45° FOV · image size 2352x1568 · CFP
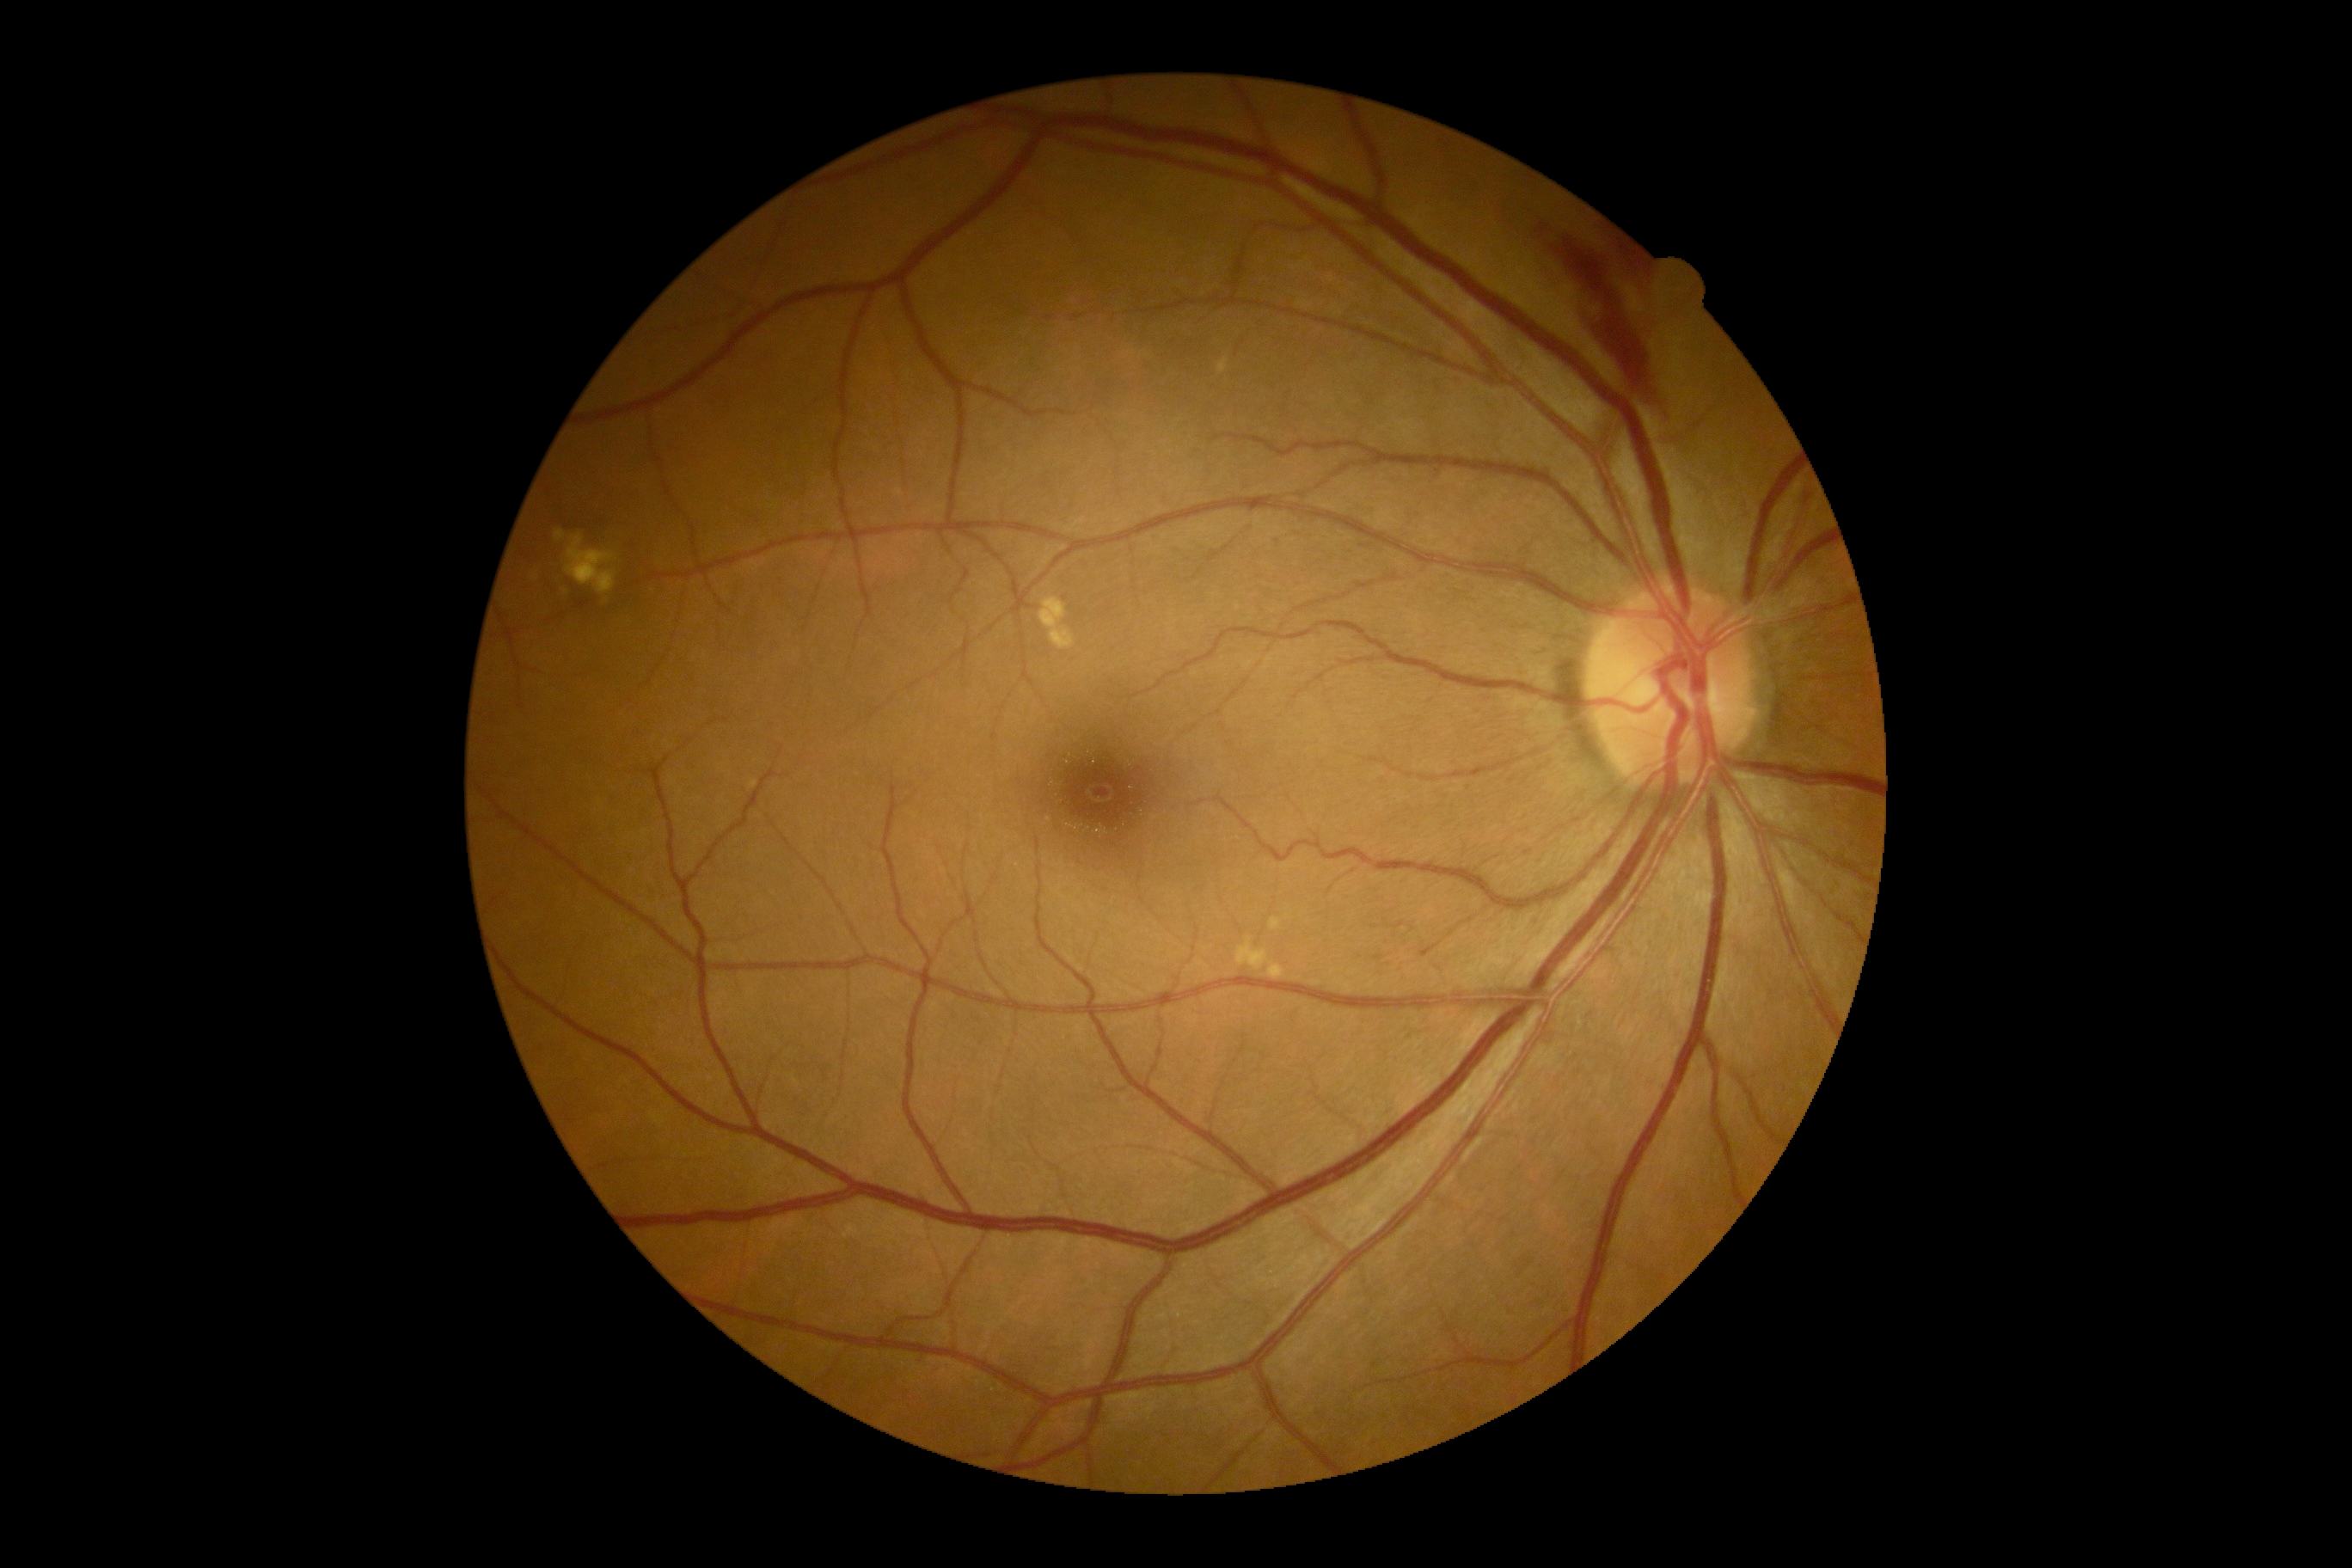
DR grade is moderate NPDR (2). DR class: non-proliferative diabetic retinopathy.